RetCam wide-field infant fundus image; Clarity RetCam 3, 130° FOV:
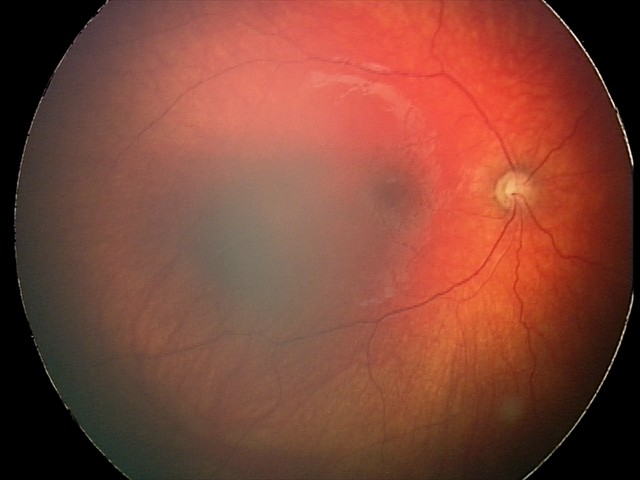
Impression = optic nerve hypoplasia.